Acquired on the Clarity RetCam 3 · RetCam wide-field infant fundus image.
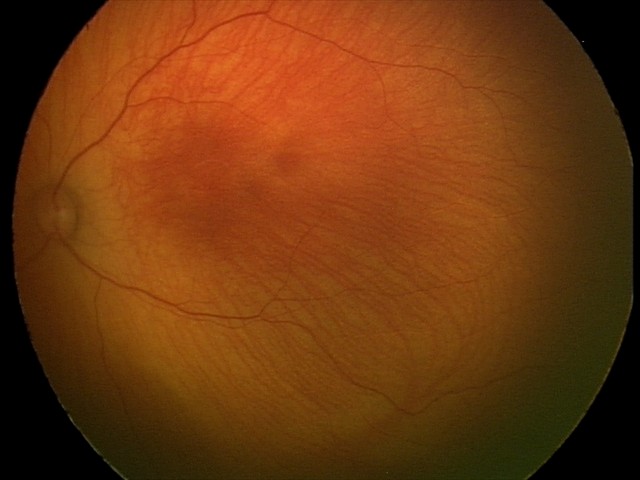
Screening examination with no abnormal retinal findings.